45° FOV.
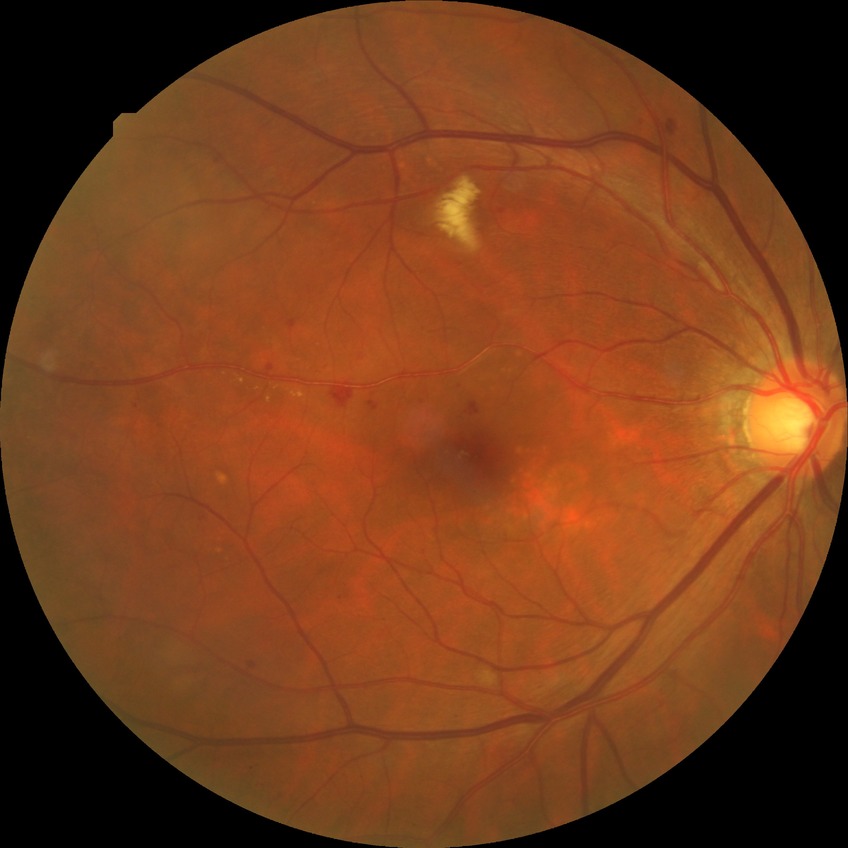   davis_grade: PPDR (pre-proliferative diabetic retinopathy)